Camera: NIDEK AFC-230. Davis DR grading: 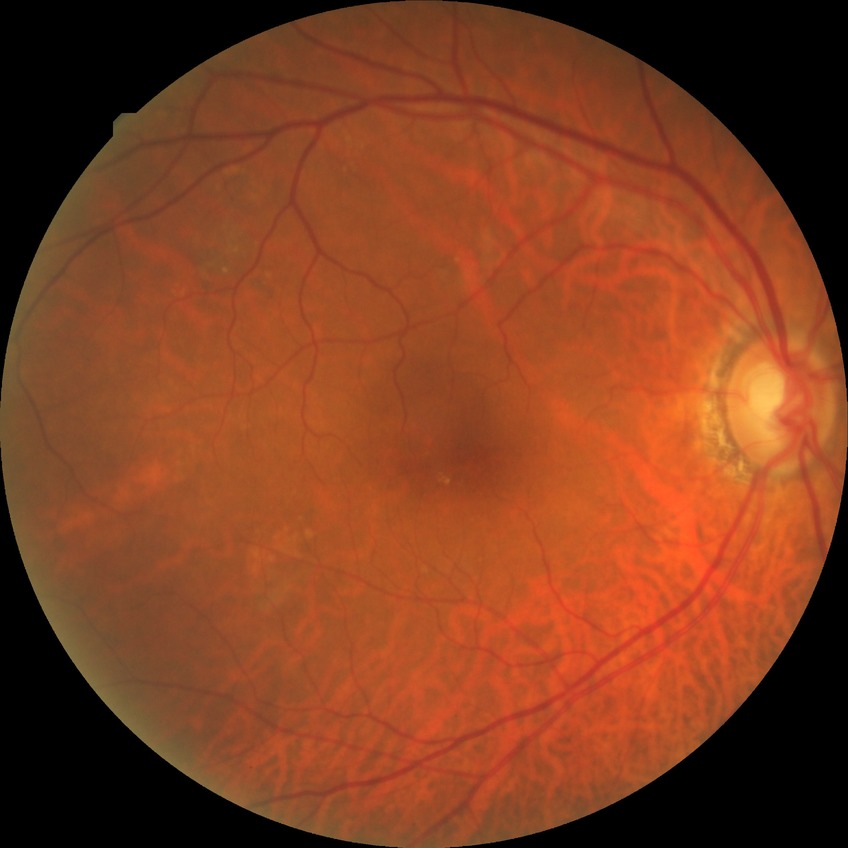
- Davis DR grade: NDR